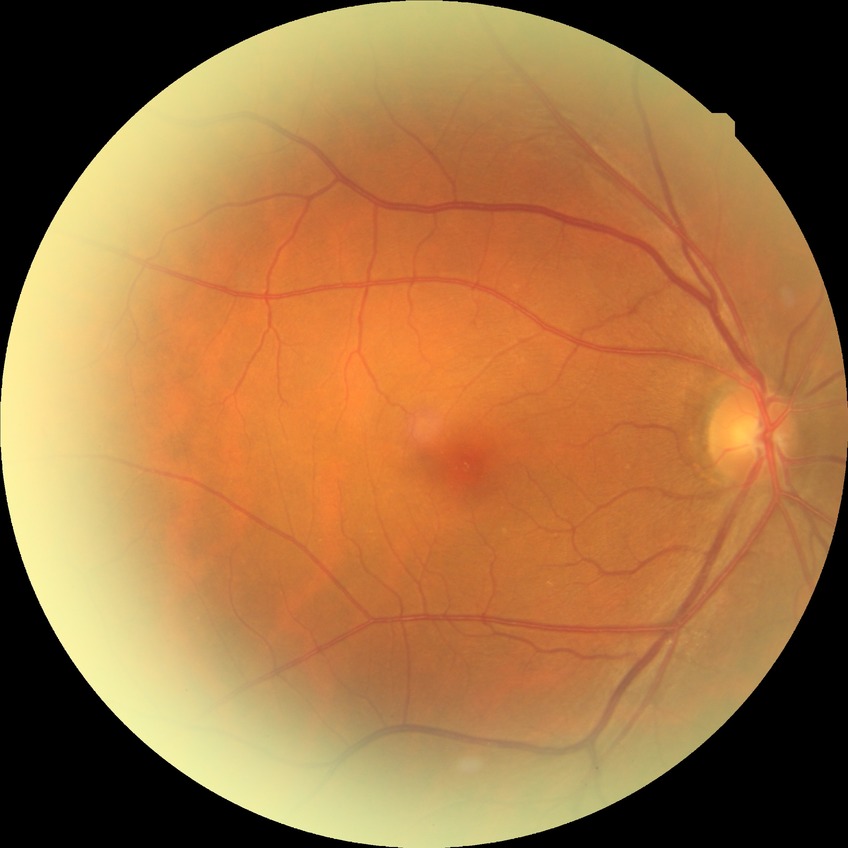
Diabetic retinopathy stage: no diabetic retinopathy.